848 x 848 pixels. Modified Davis grading.
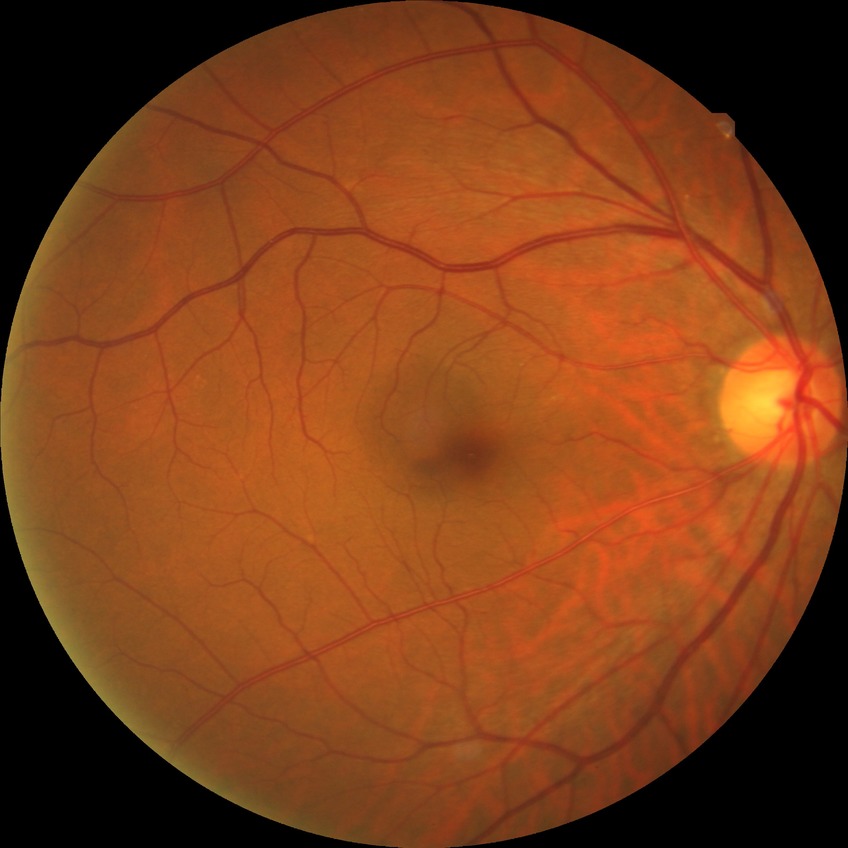

Modified Davis grade: NDR.